NIDEK AFC-230. Without pupil dilation. 848 by 848 pixels. 45° FOV: 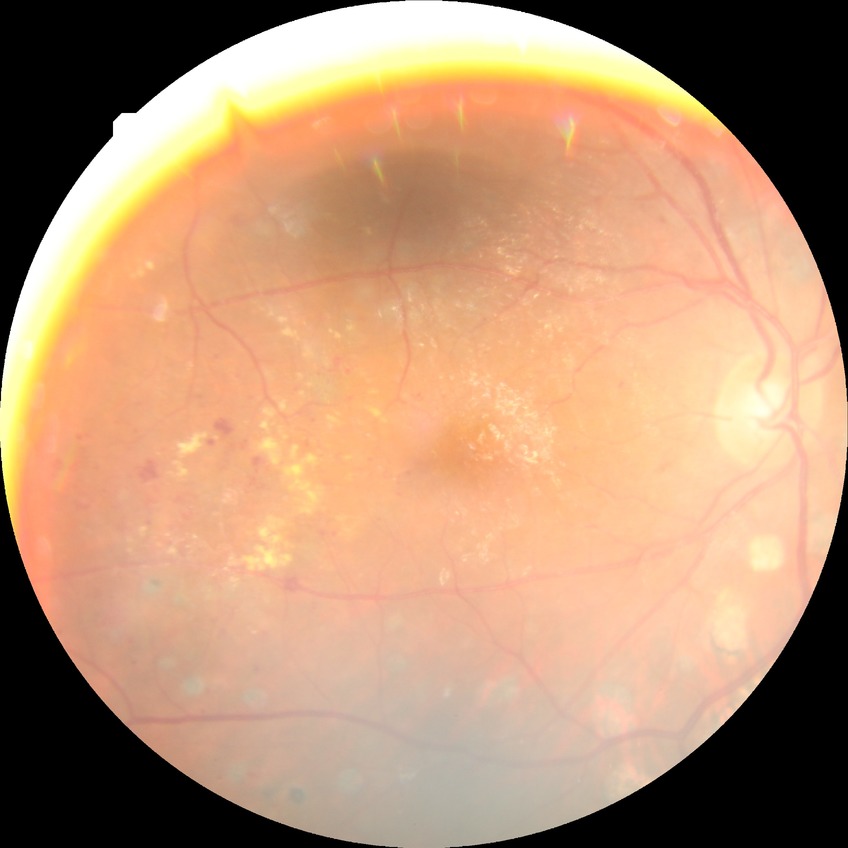 diabetic retinopathy (DR)@PDR (proliferative diabetic retinopathy).